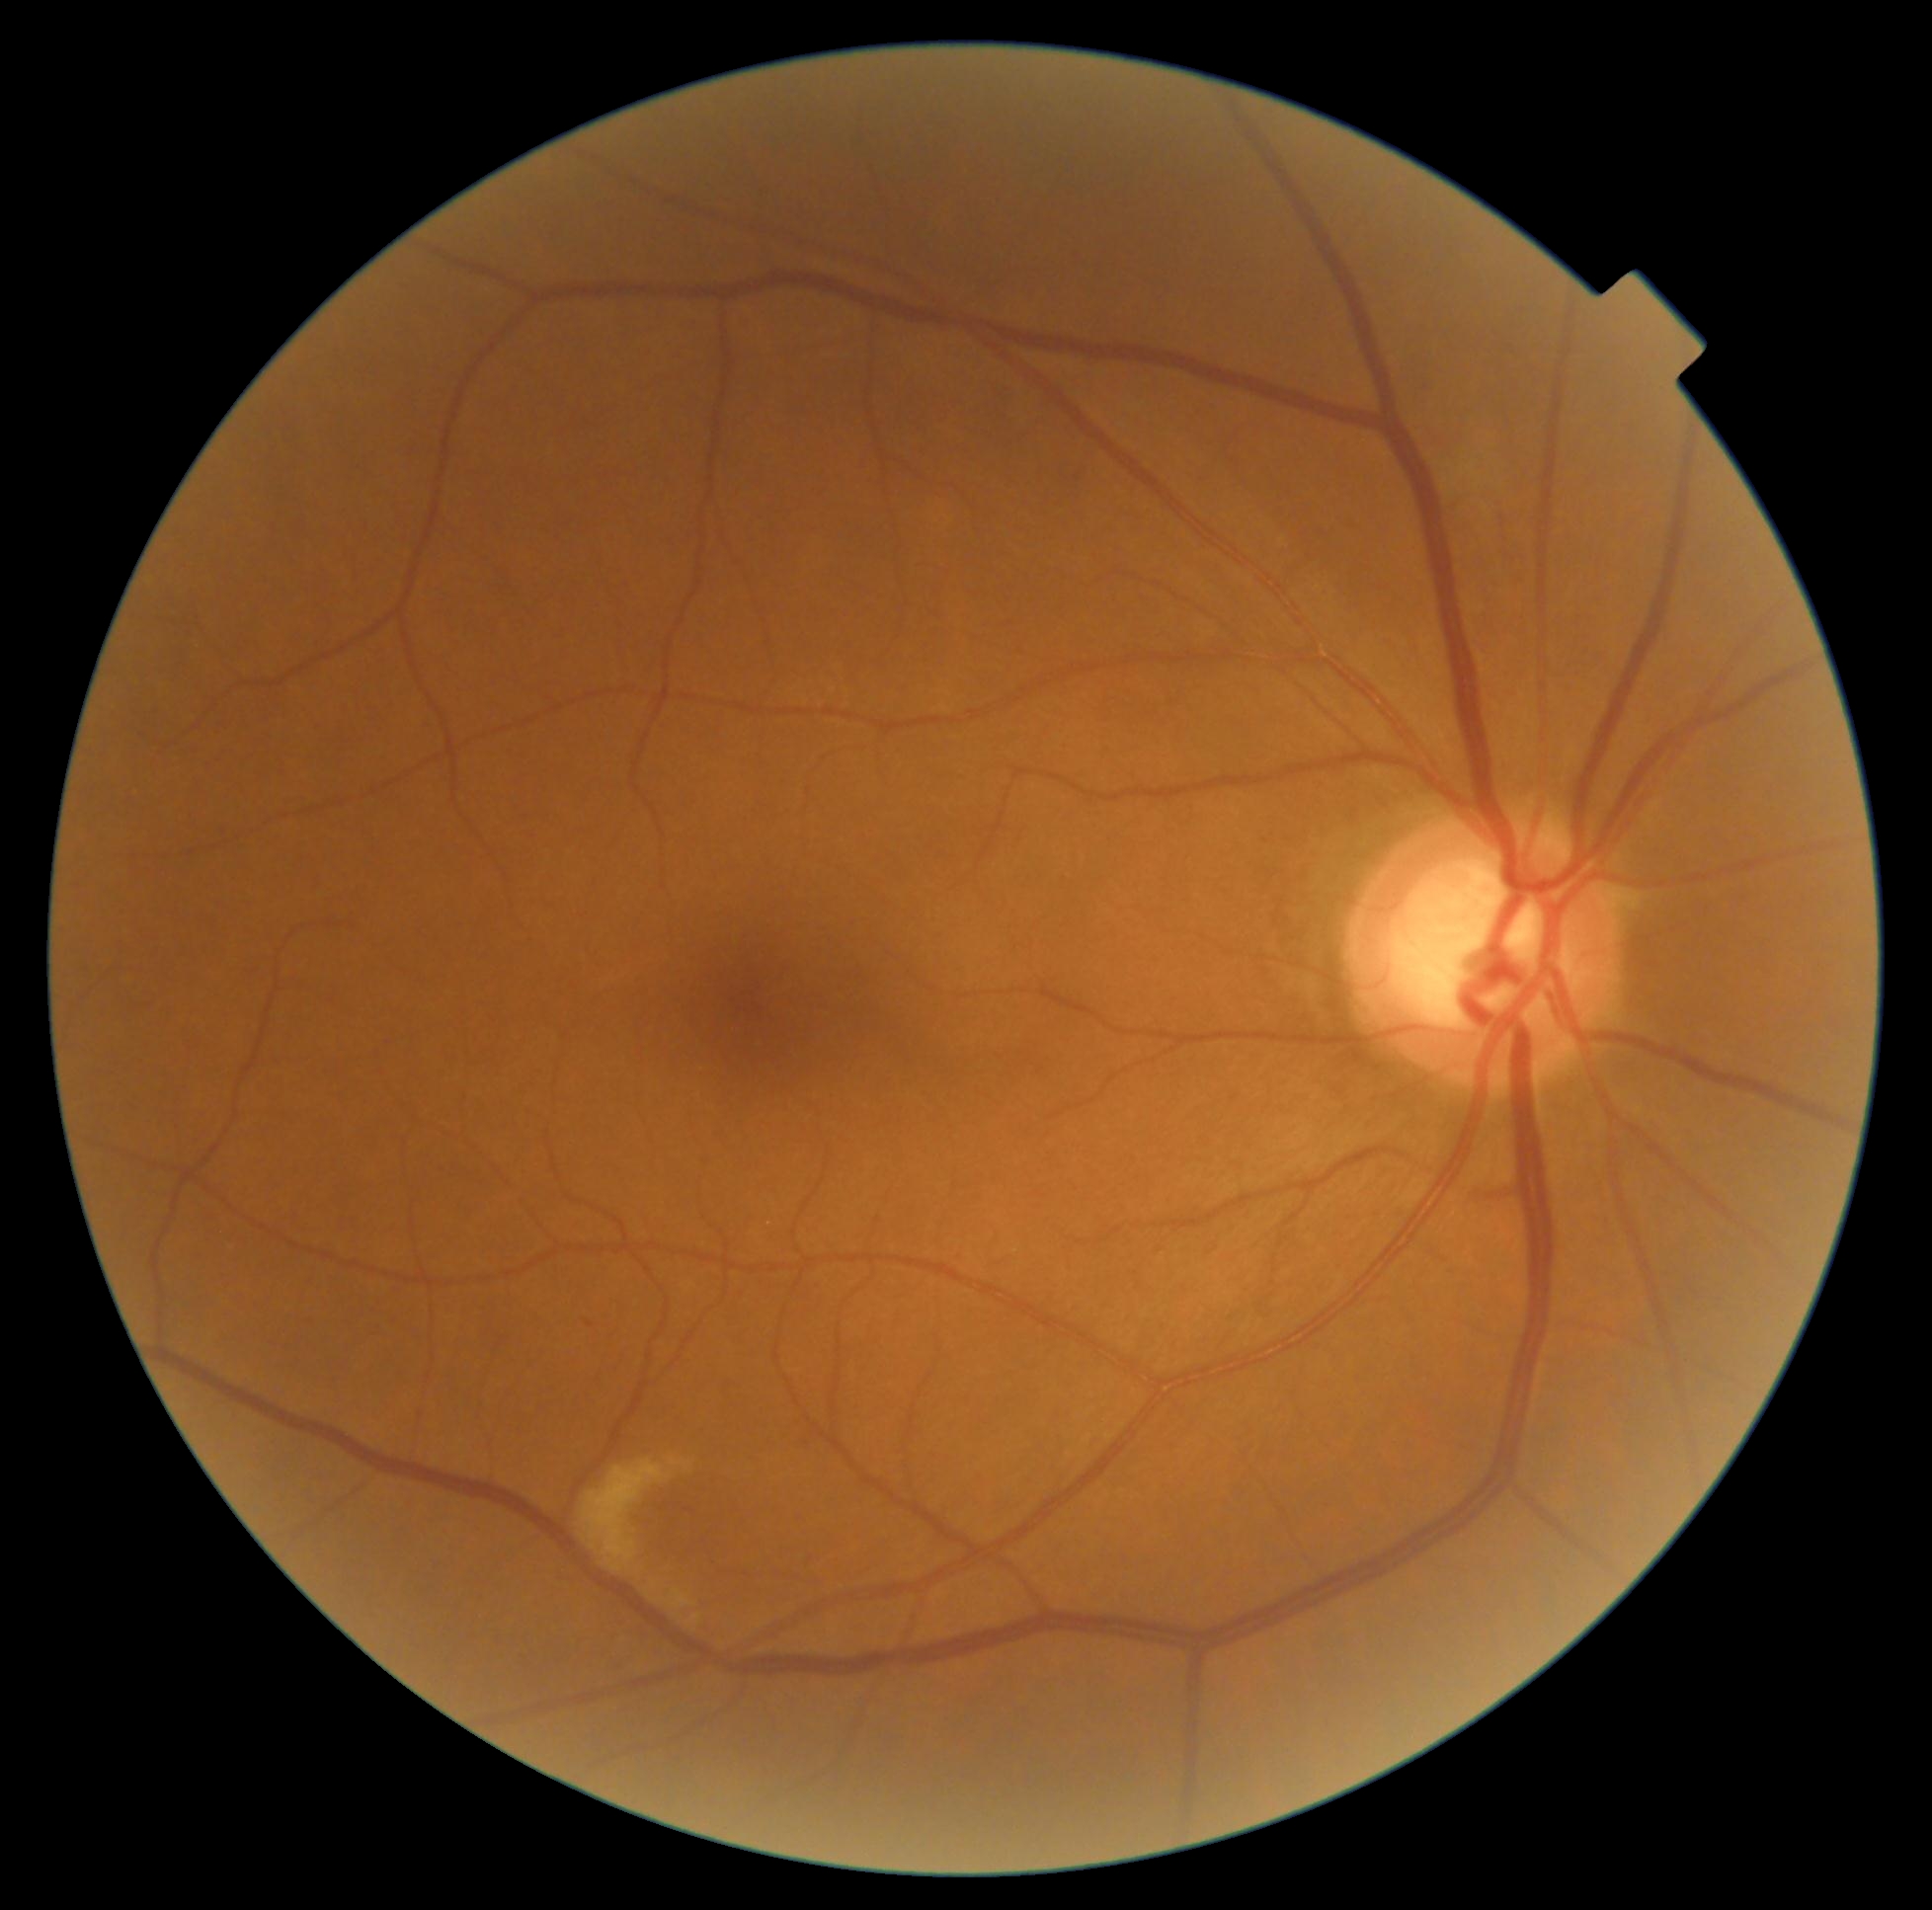 Diabetic retinopathy (DR) is grade 2. The retinopathy is classified as non-proliferative diabetic retinopathy.